Retinal fundus photograph: 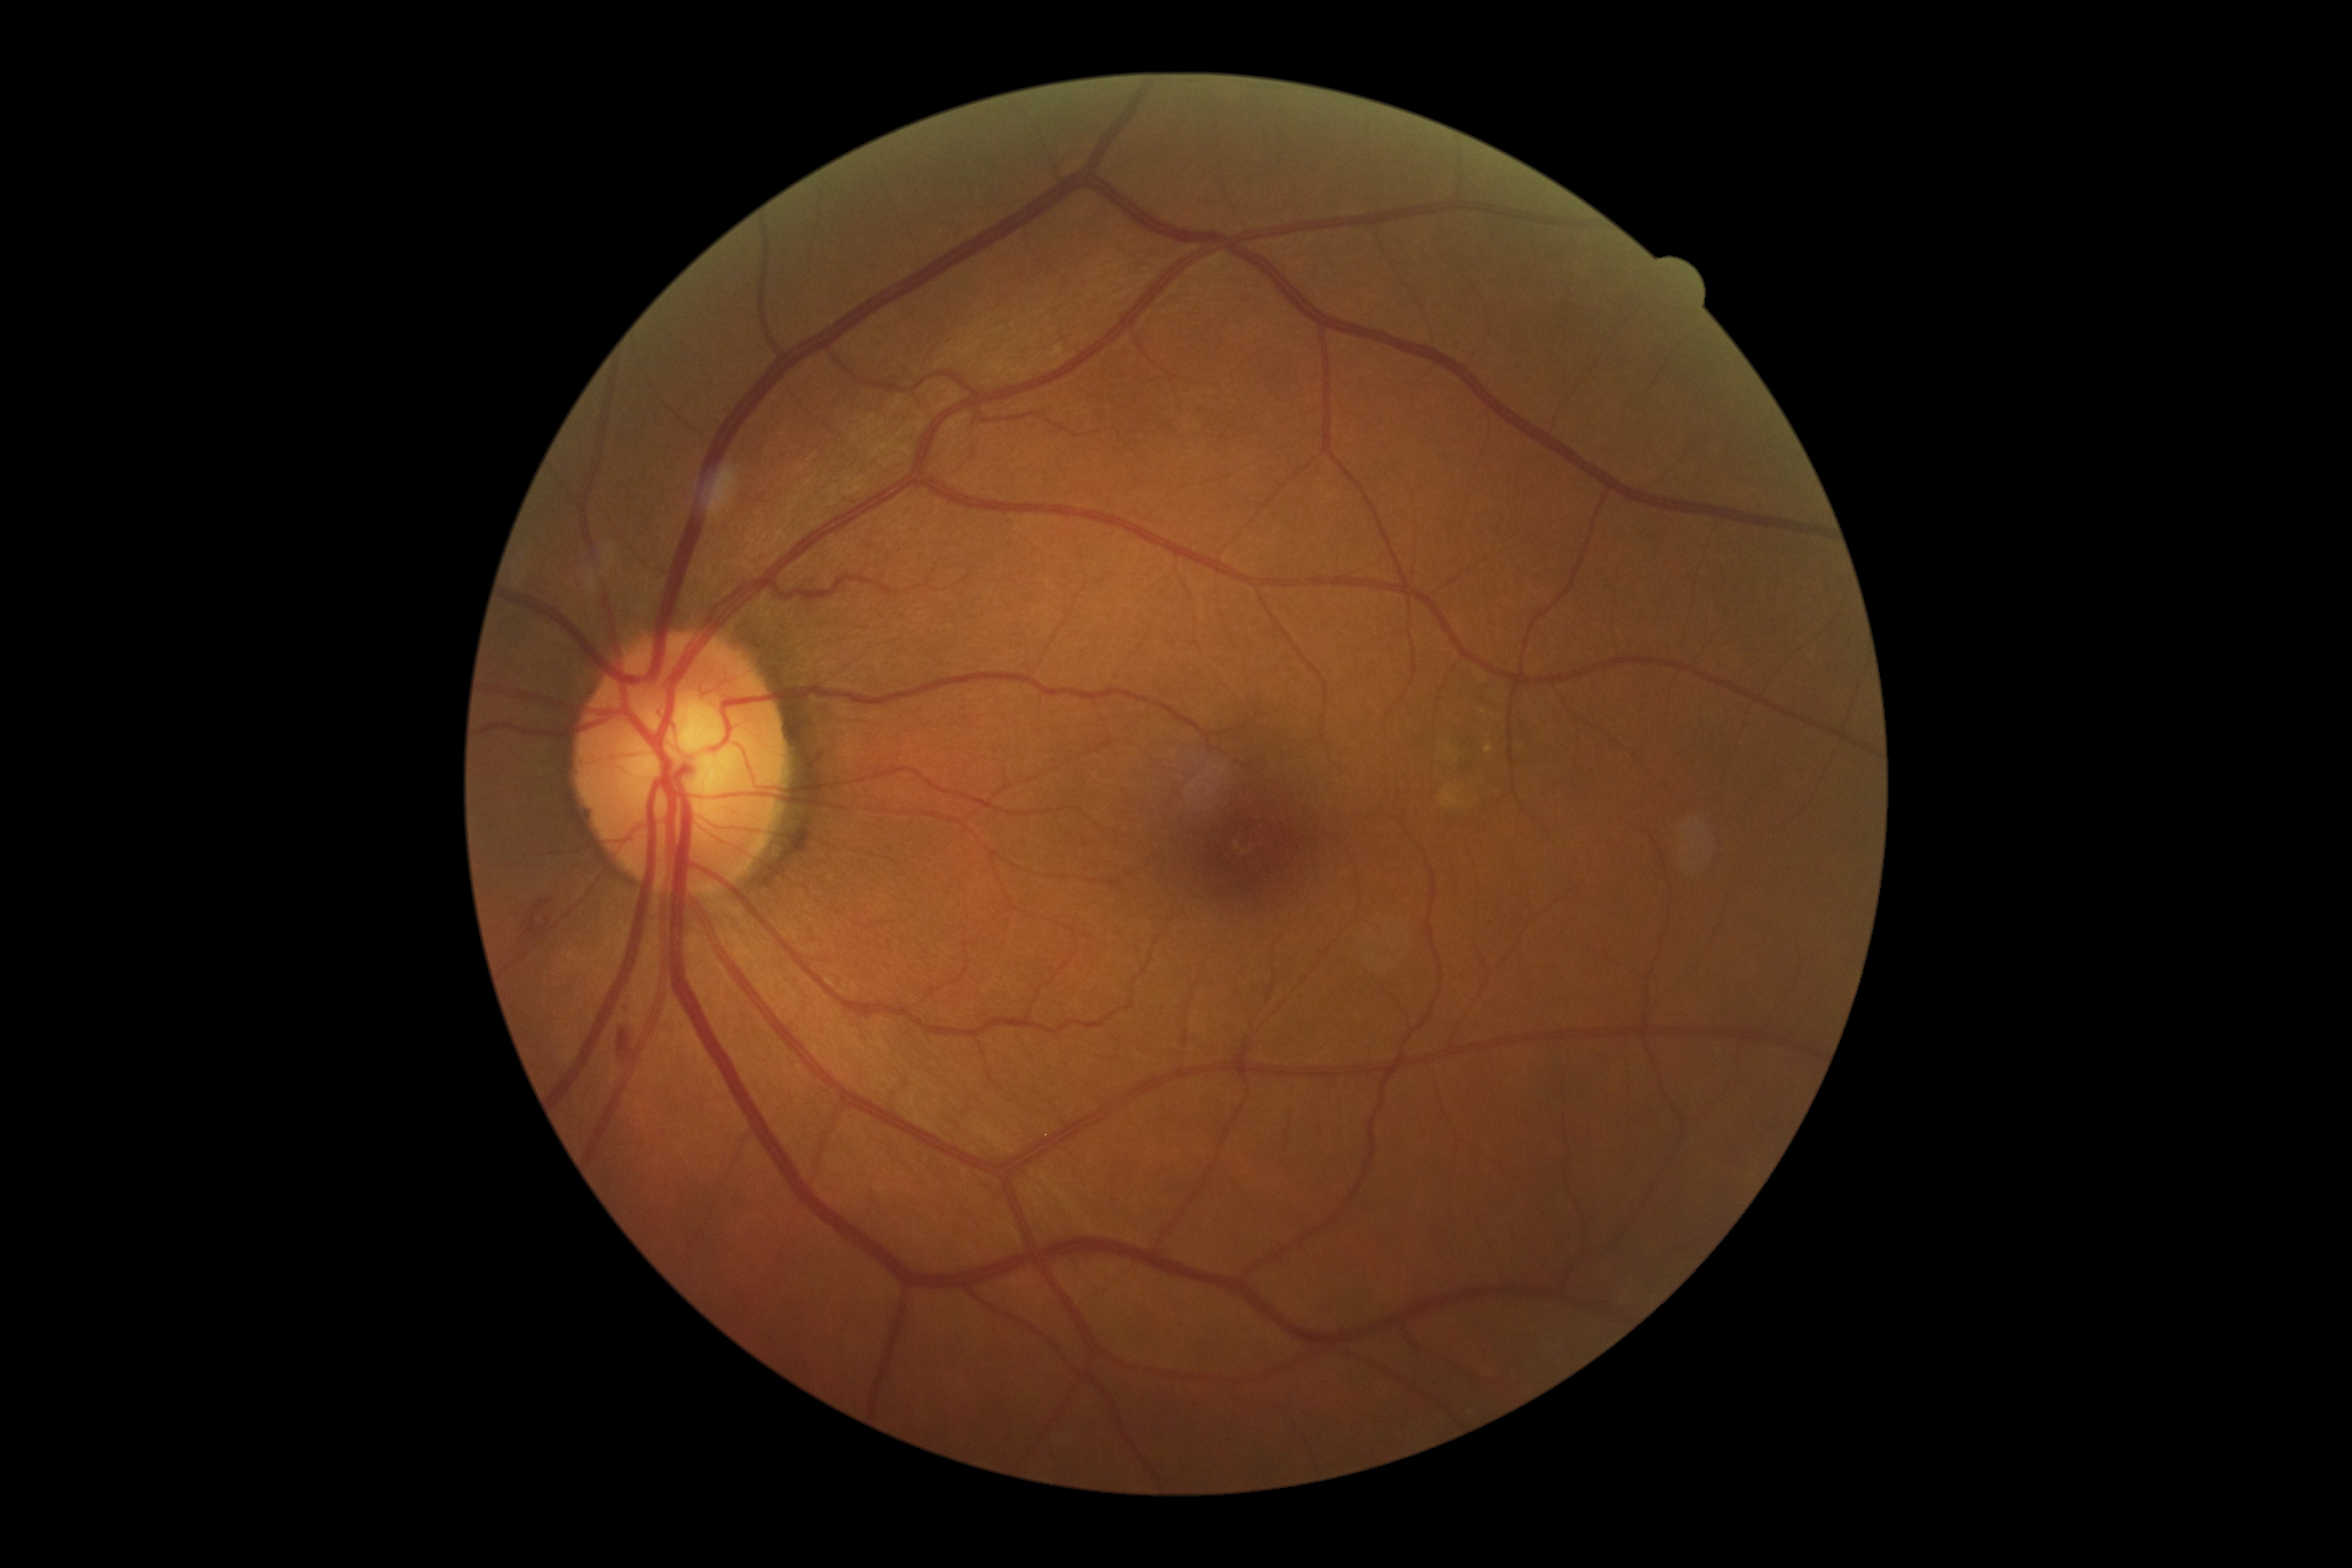 DR grade is 2/4. The retinopathy is classified as non-proliferative diabetic retinopathy.